Field includes the optic disc and macula — 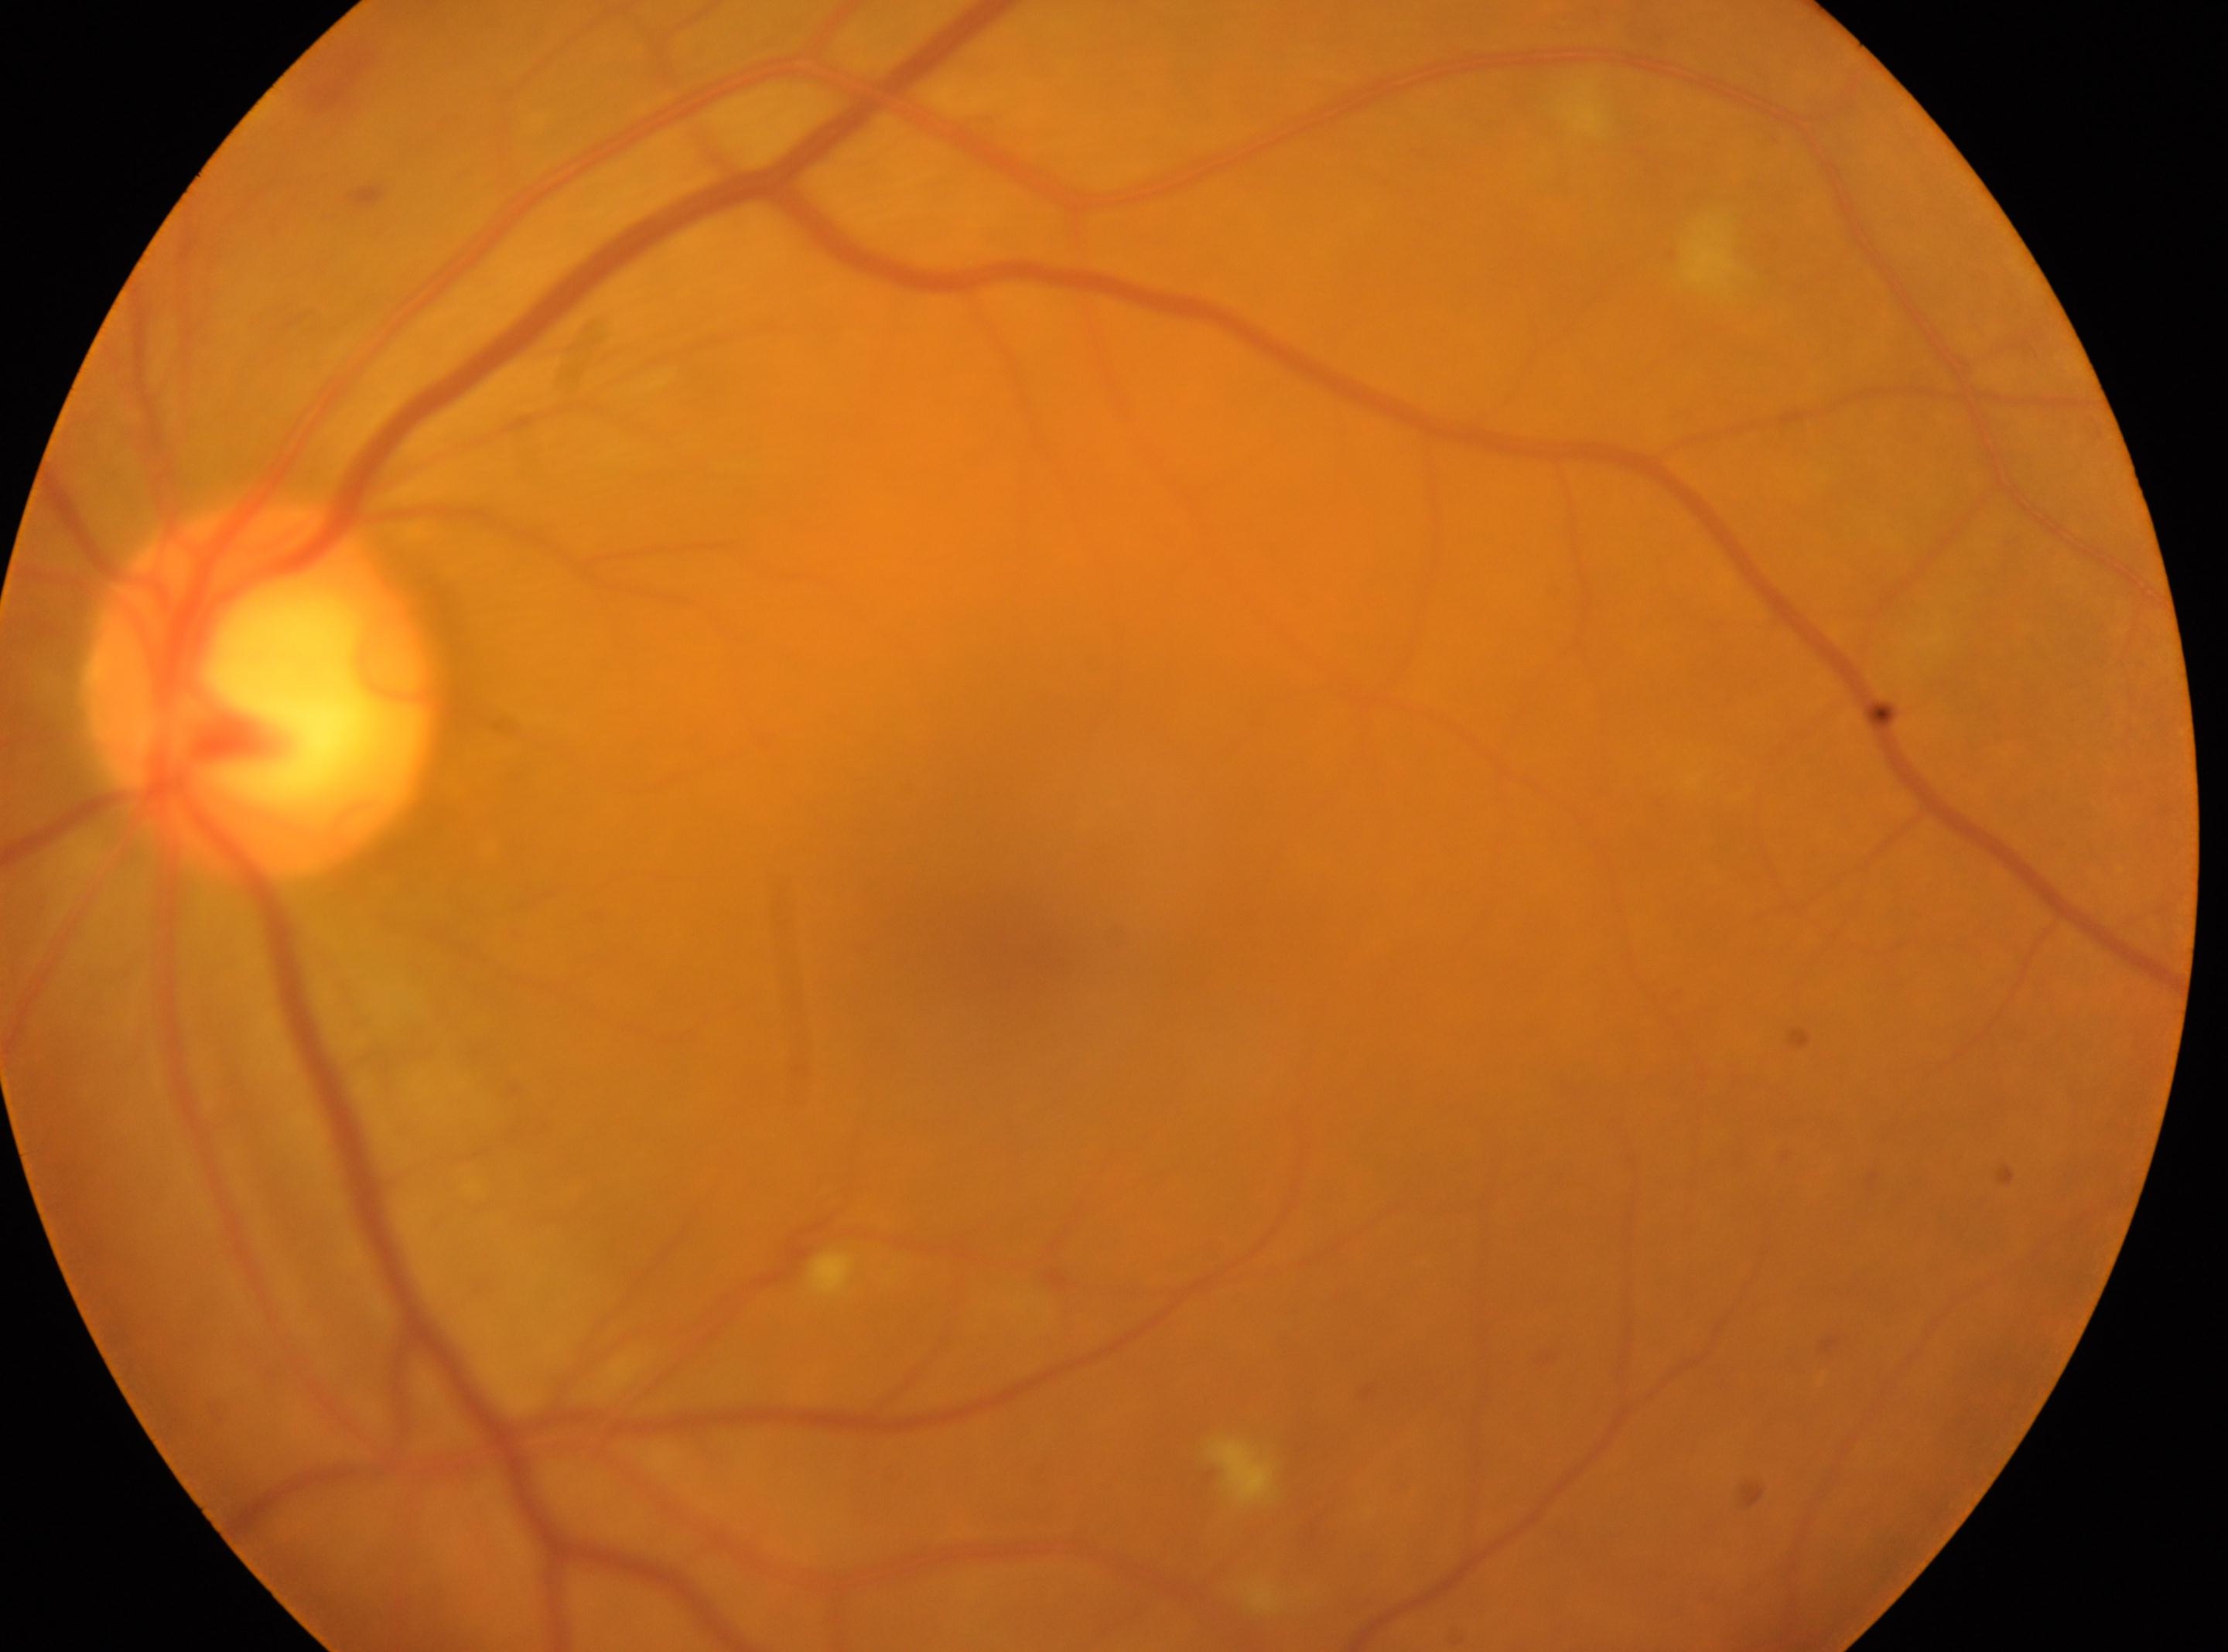

ONH: 261px, 687px. The fovea centralis is at 1029px, 945px. The image shows the left eye. DR grade: 2/4.